Color fundus image
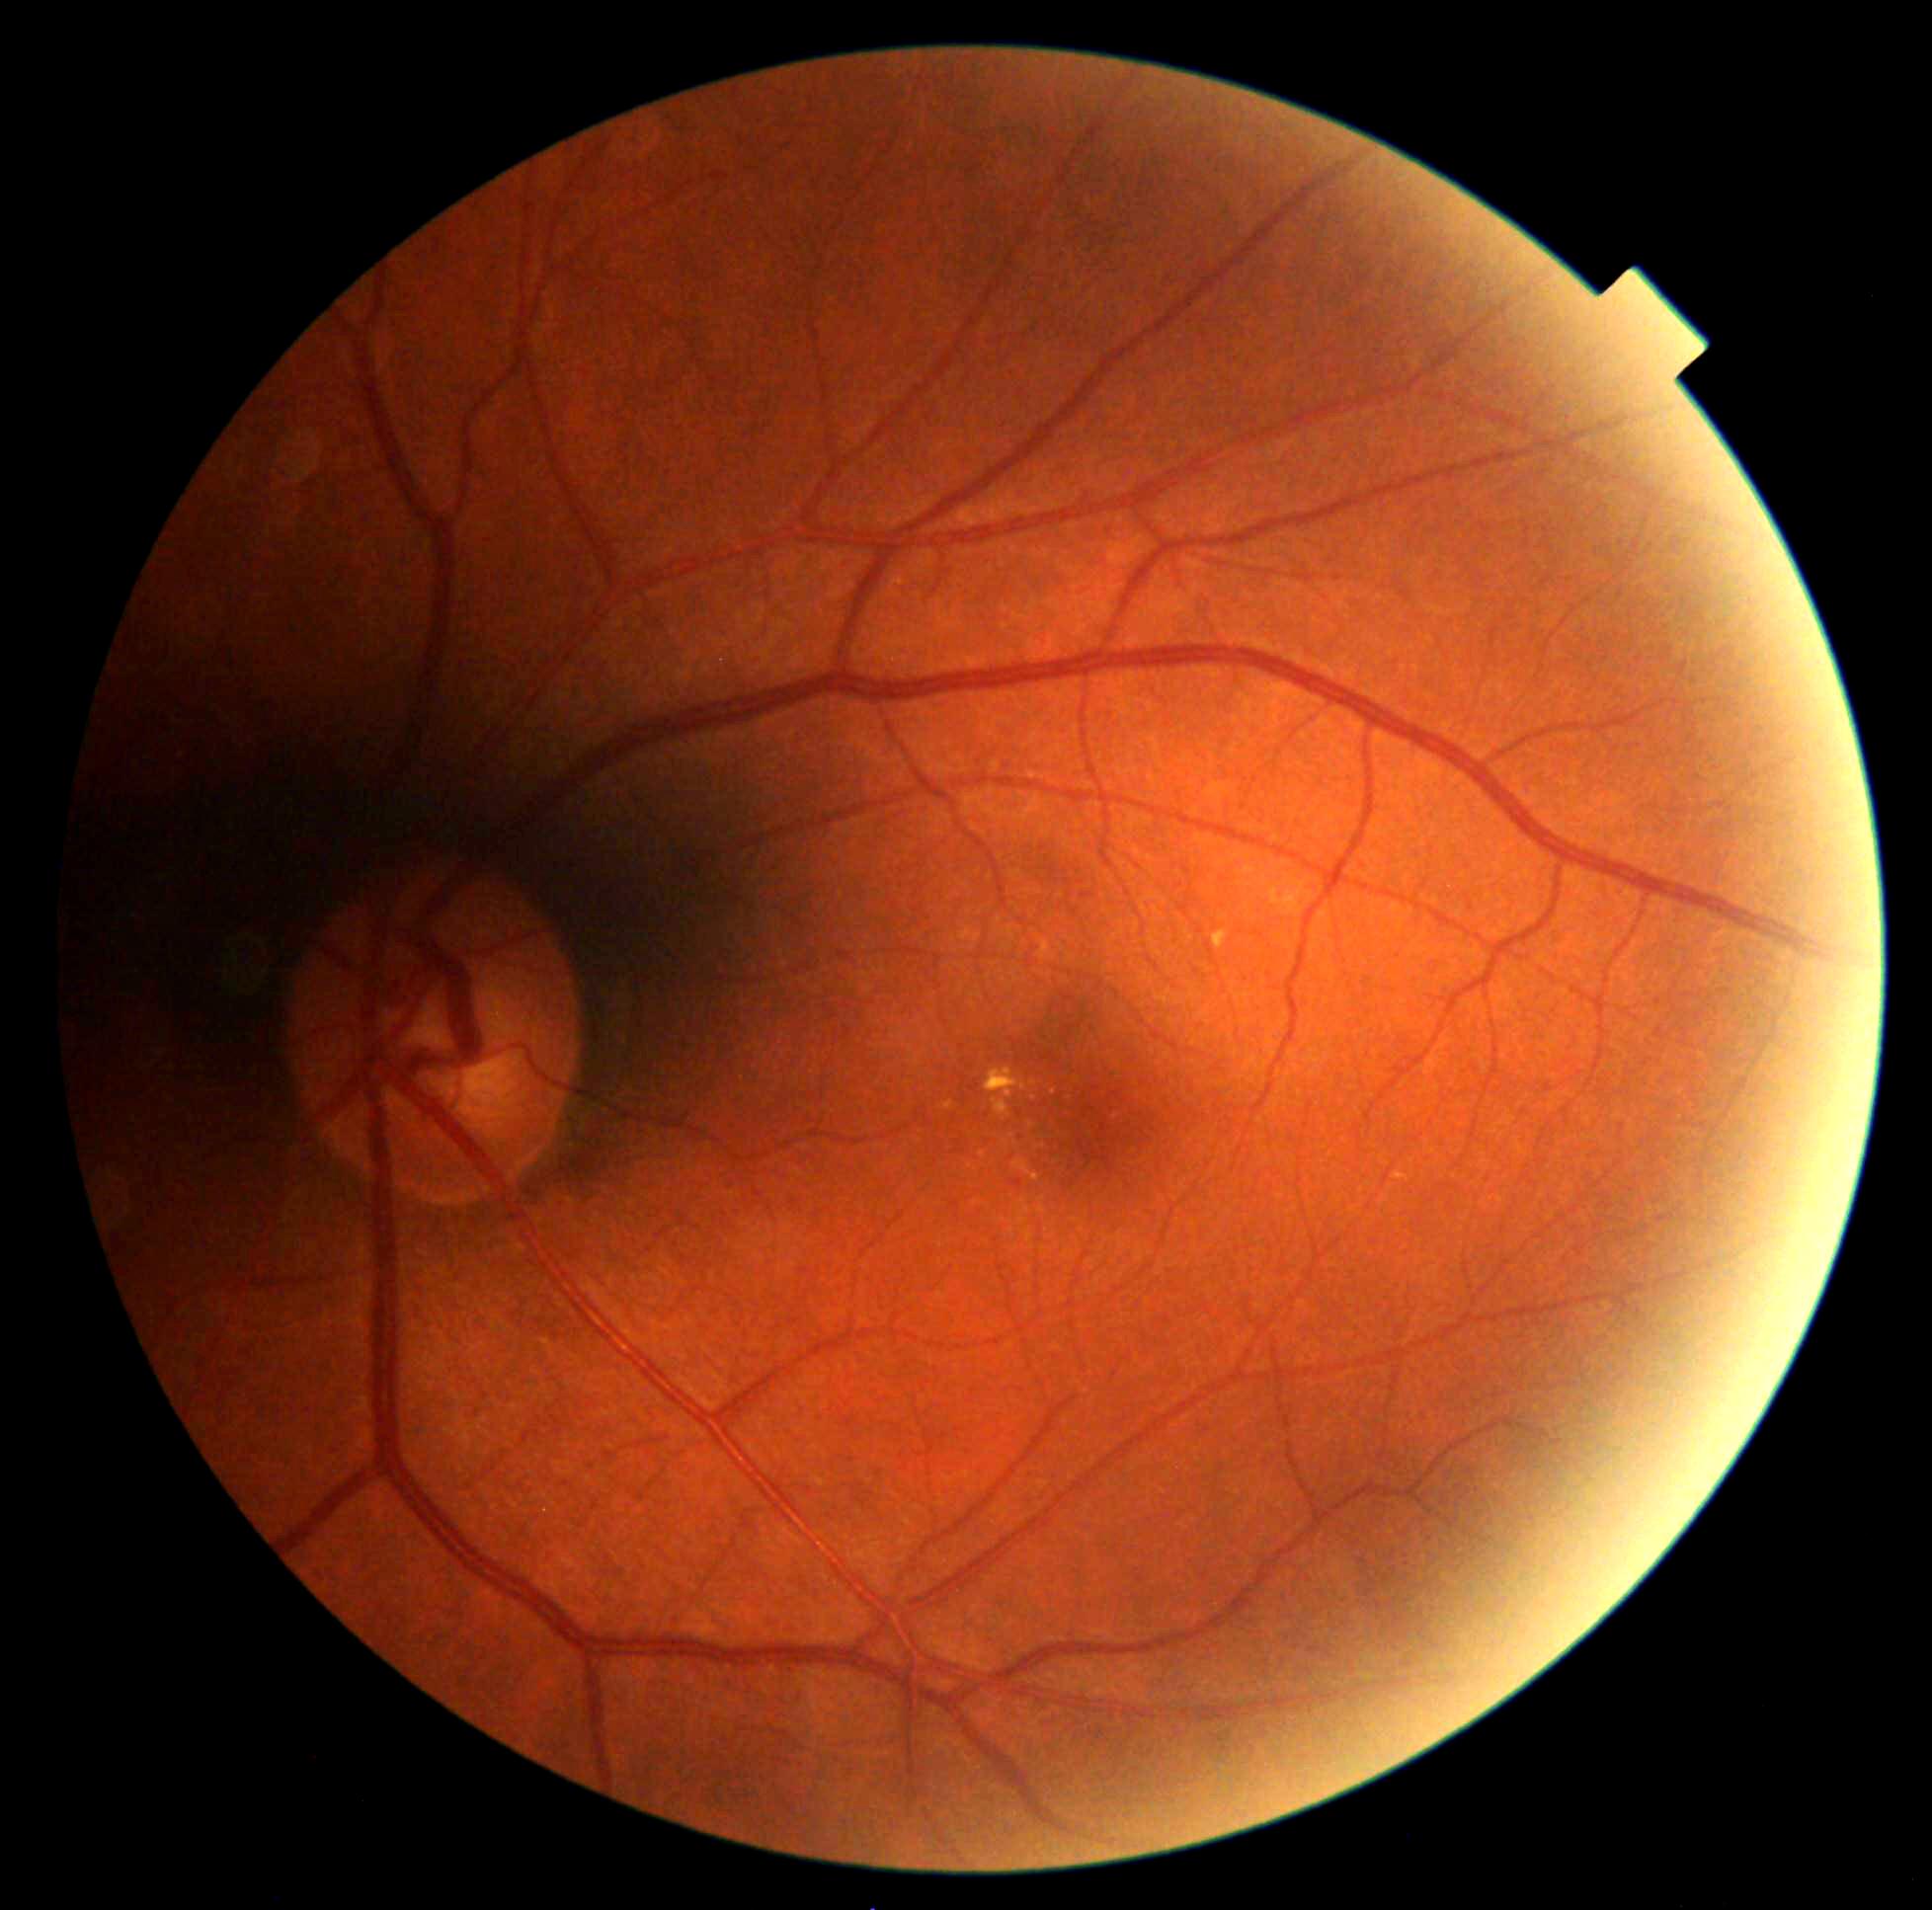 Diabetic retinopathy (DR) is grade 2.